45-degree field of view, color fundus image, 2212 by 1659 pixels
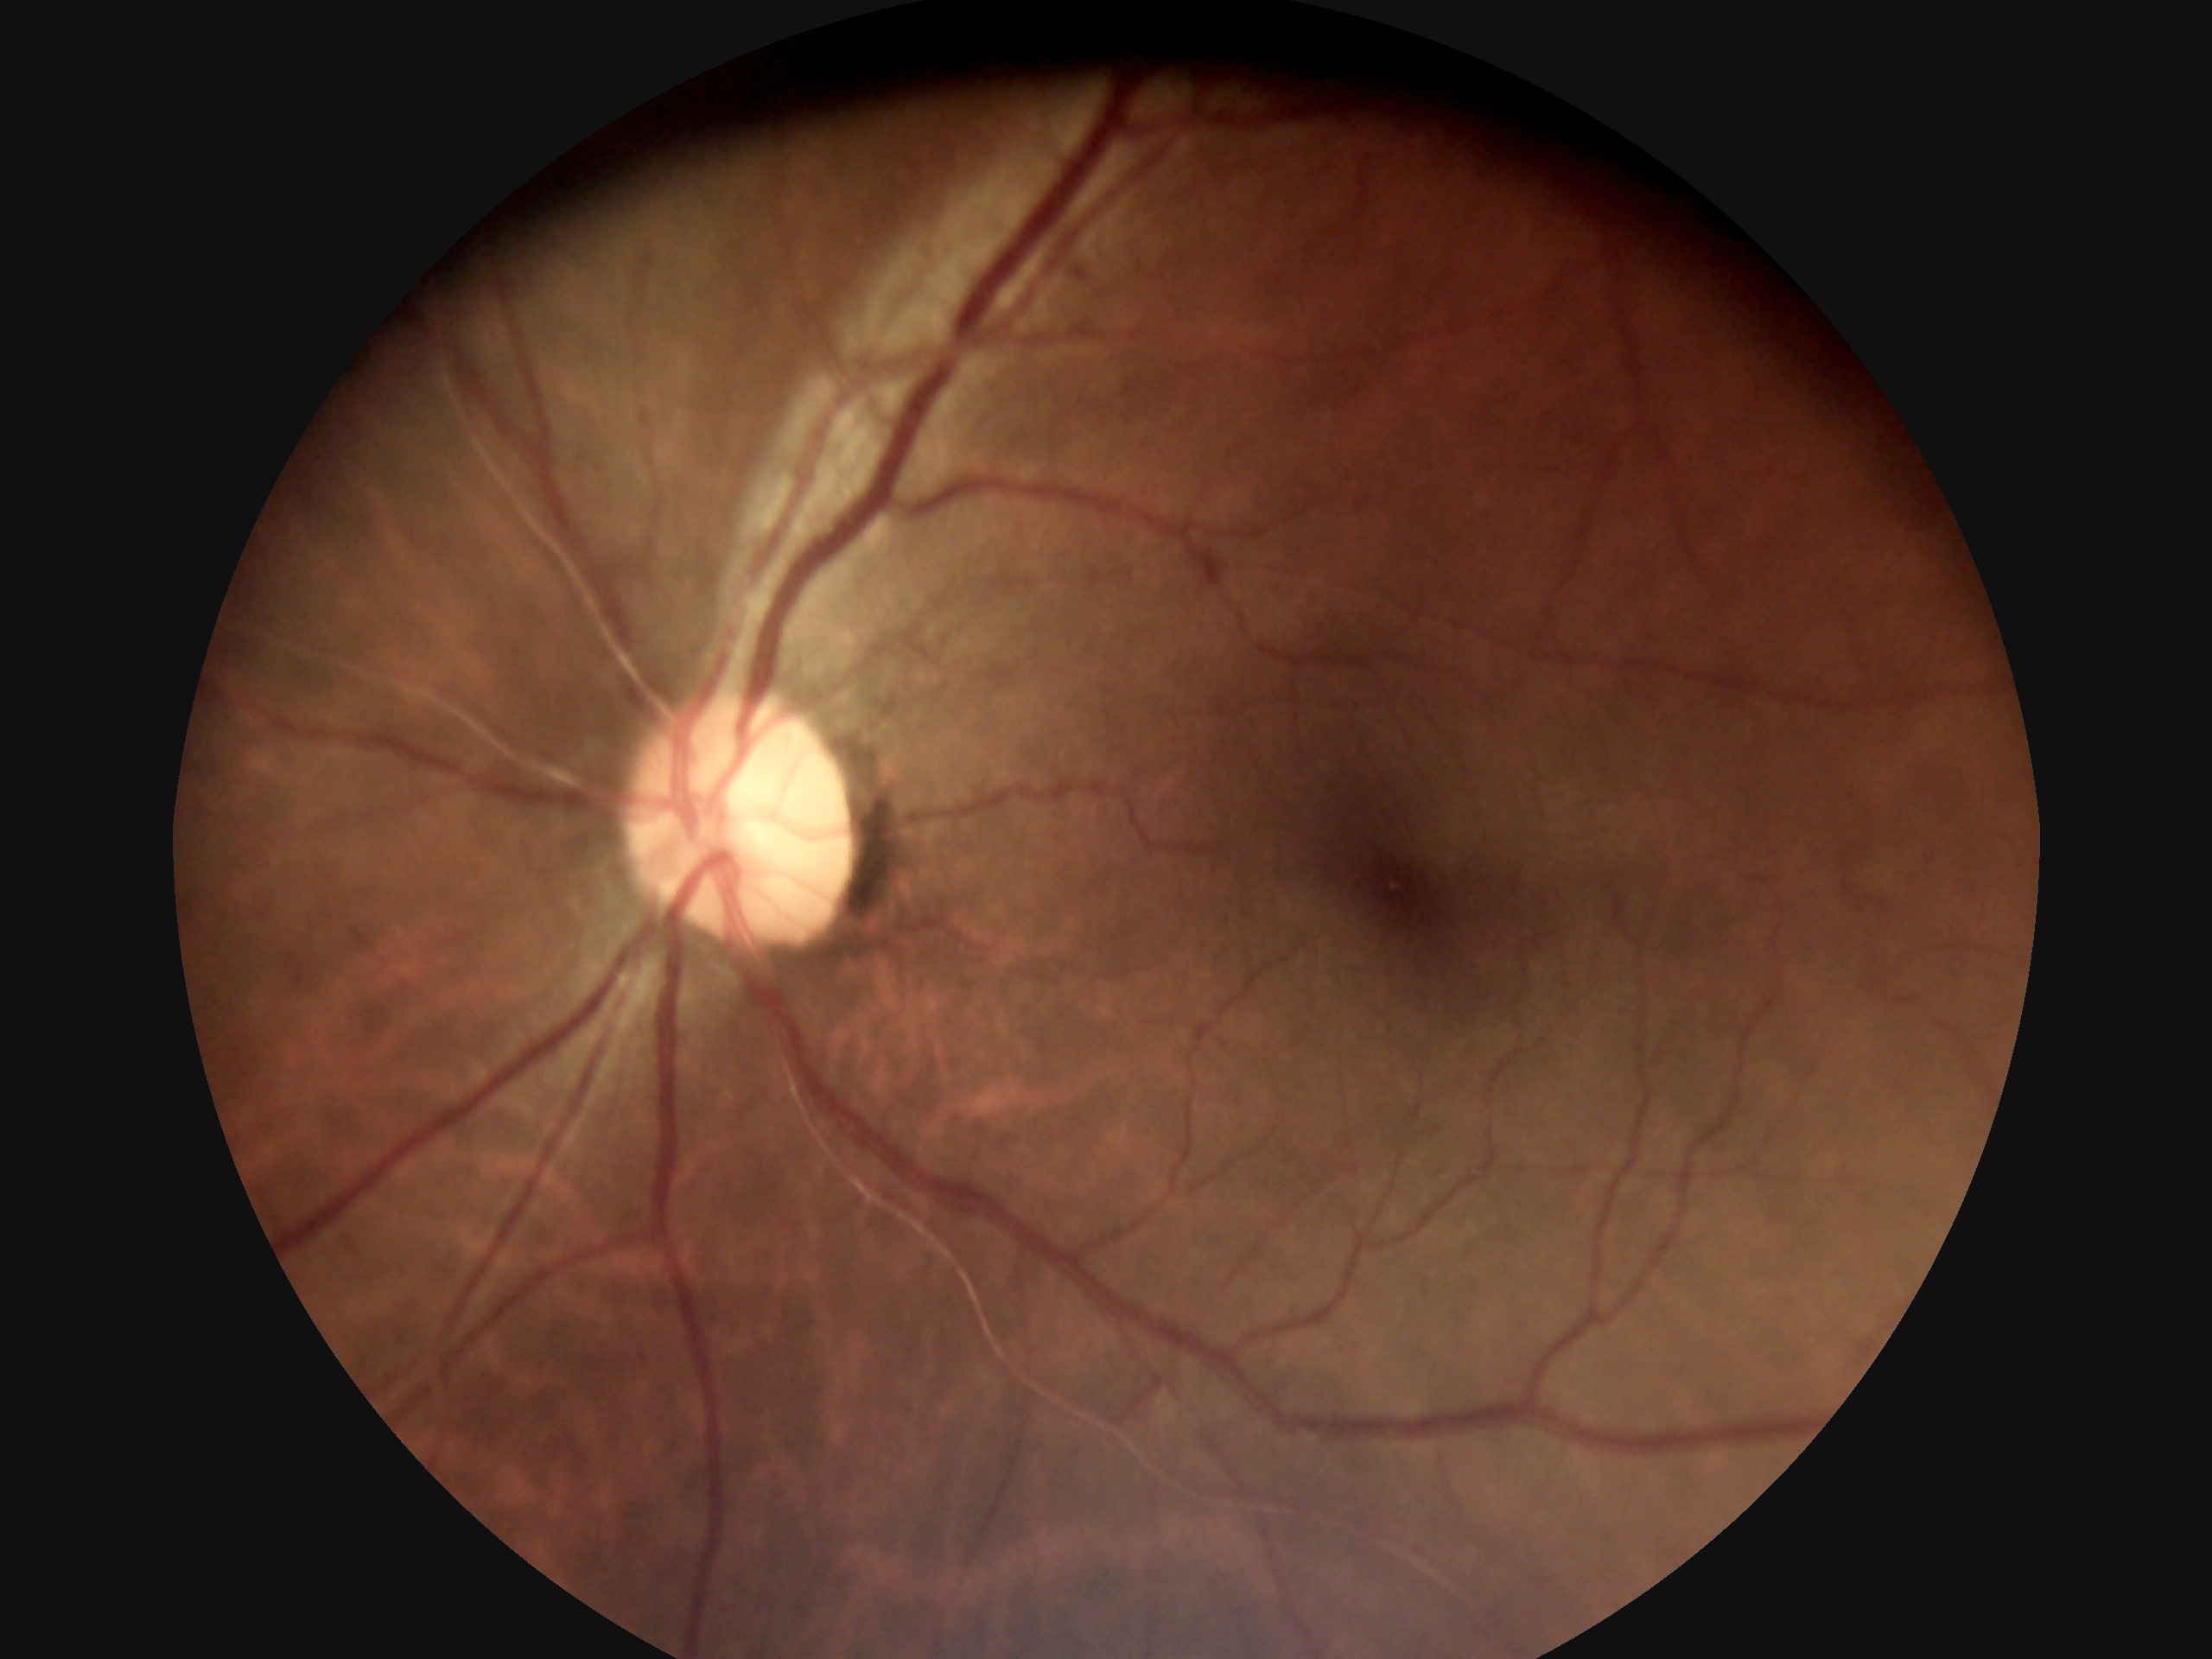

DR stage@0/4.